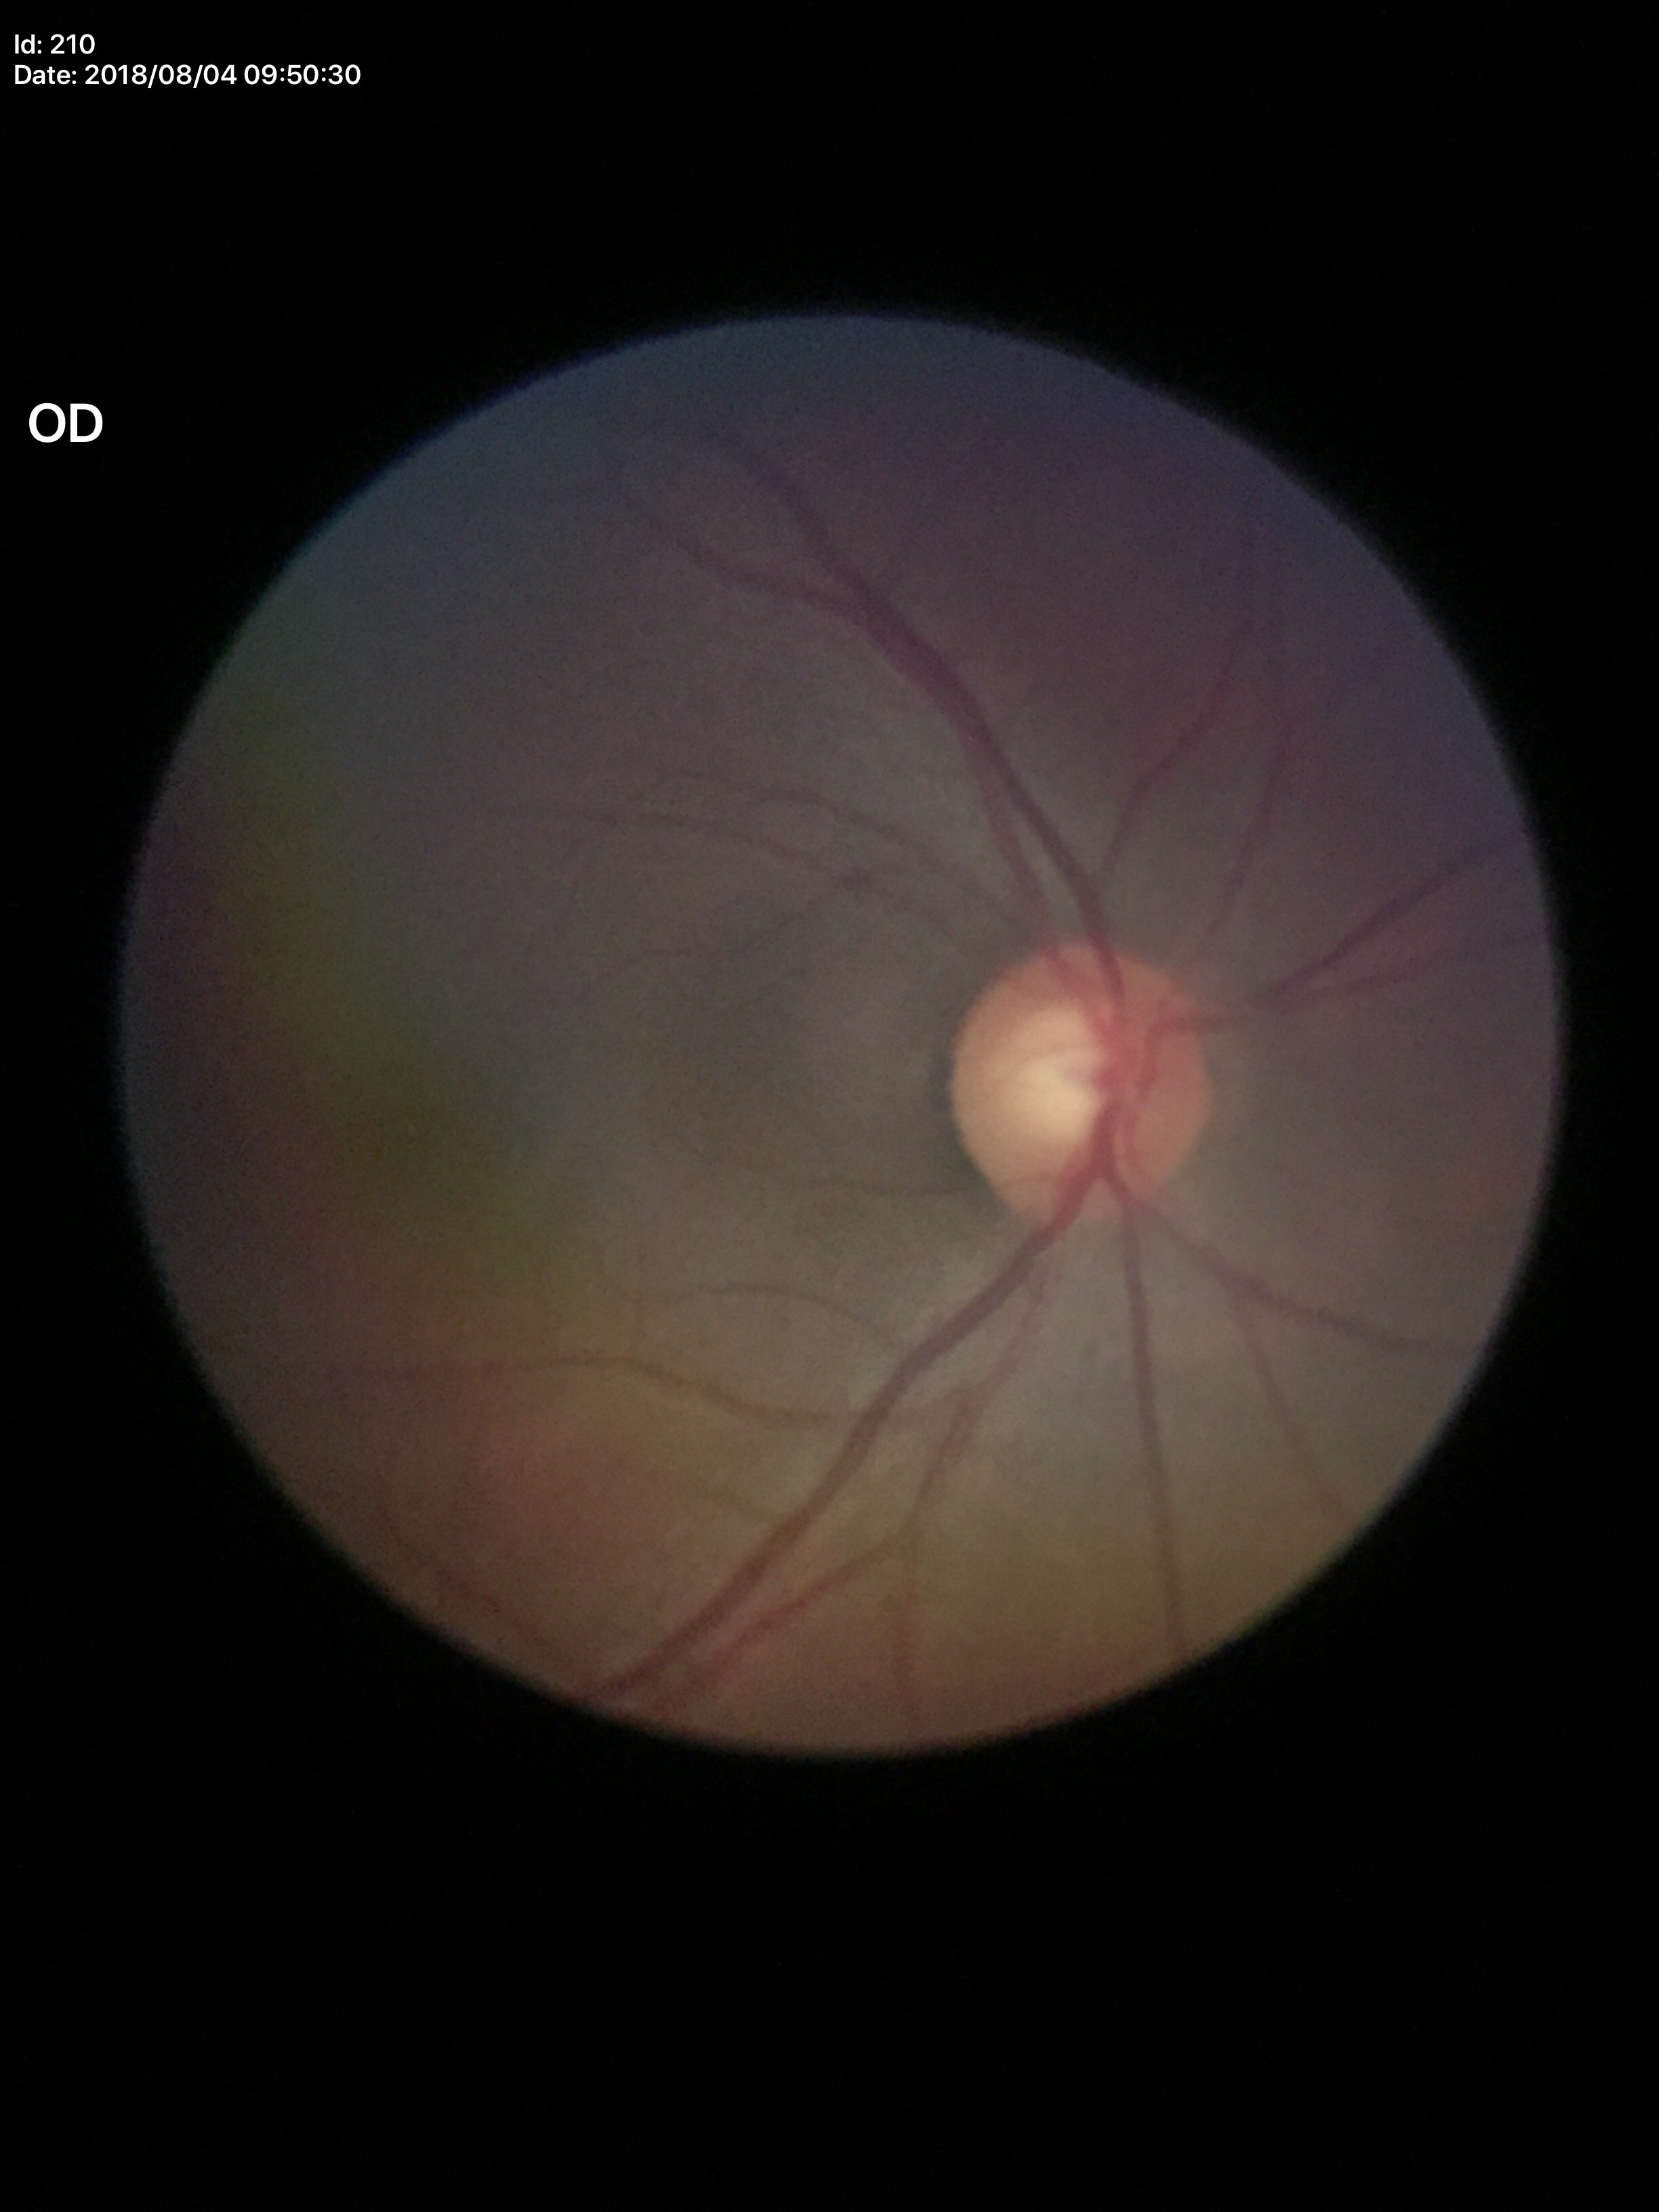

Glaucoma assessment: suspicious
vertical cup-to-disc ratio: 0.62